45 degree fundus photograph: 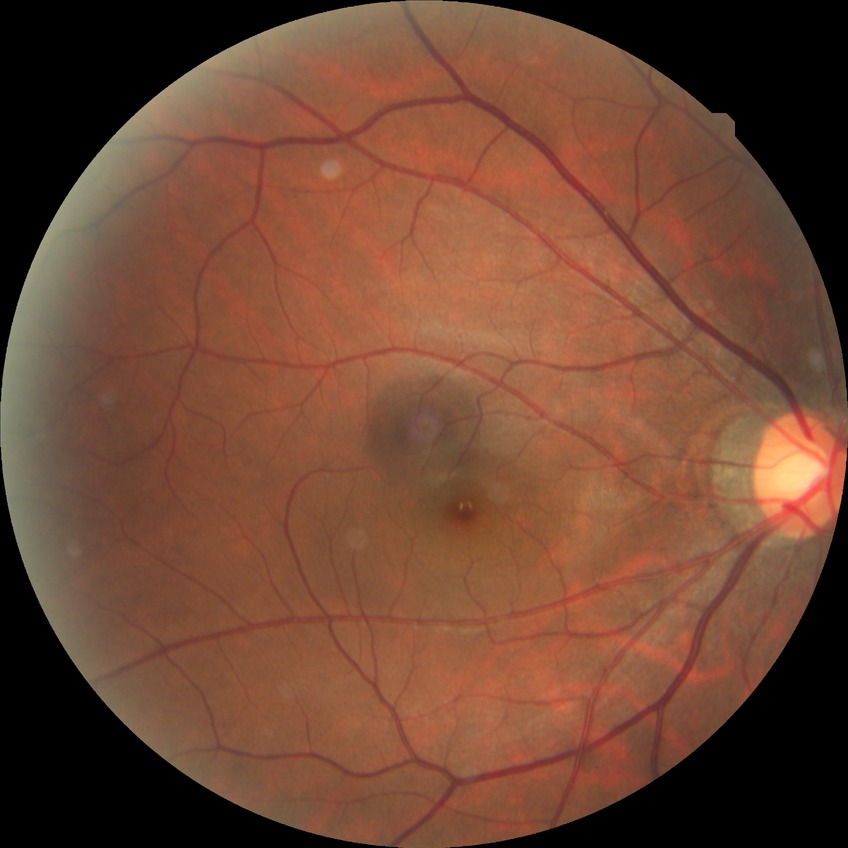

diabetic retinopathy (DR) = NDR (no diabetic retinopathy).